2352x1568px; color fundus image — 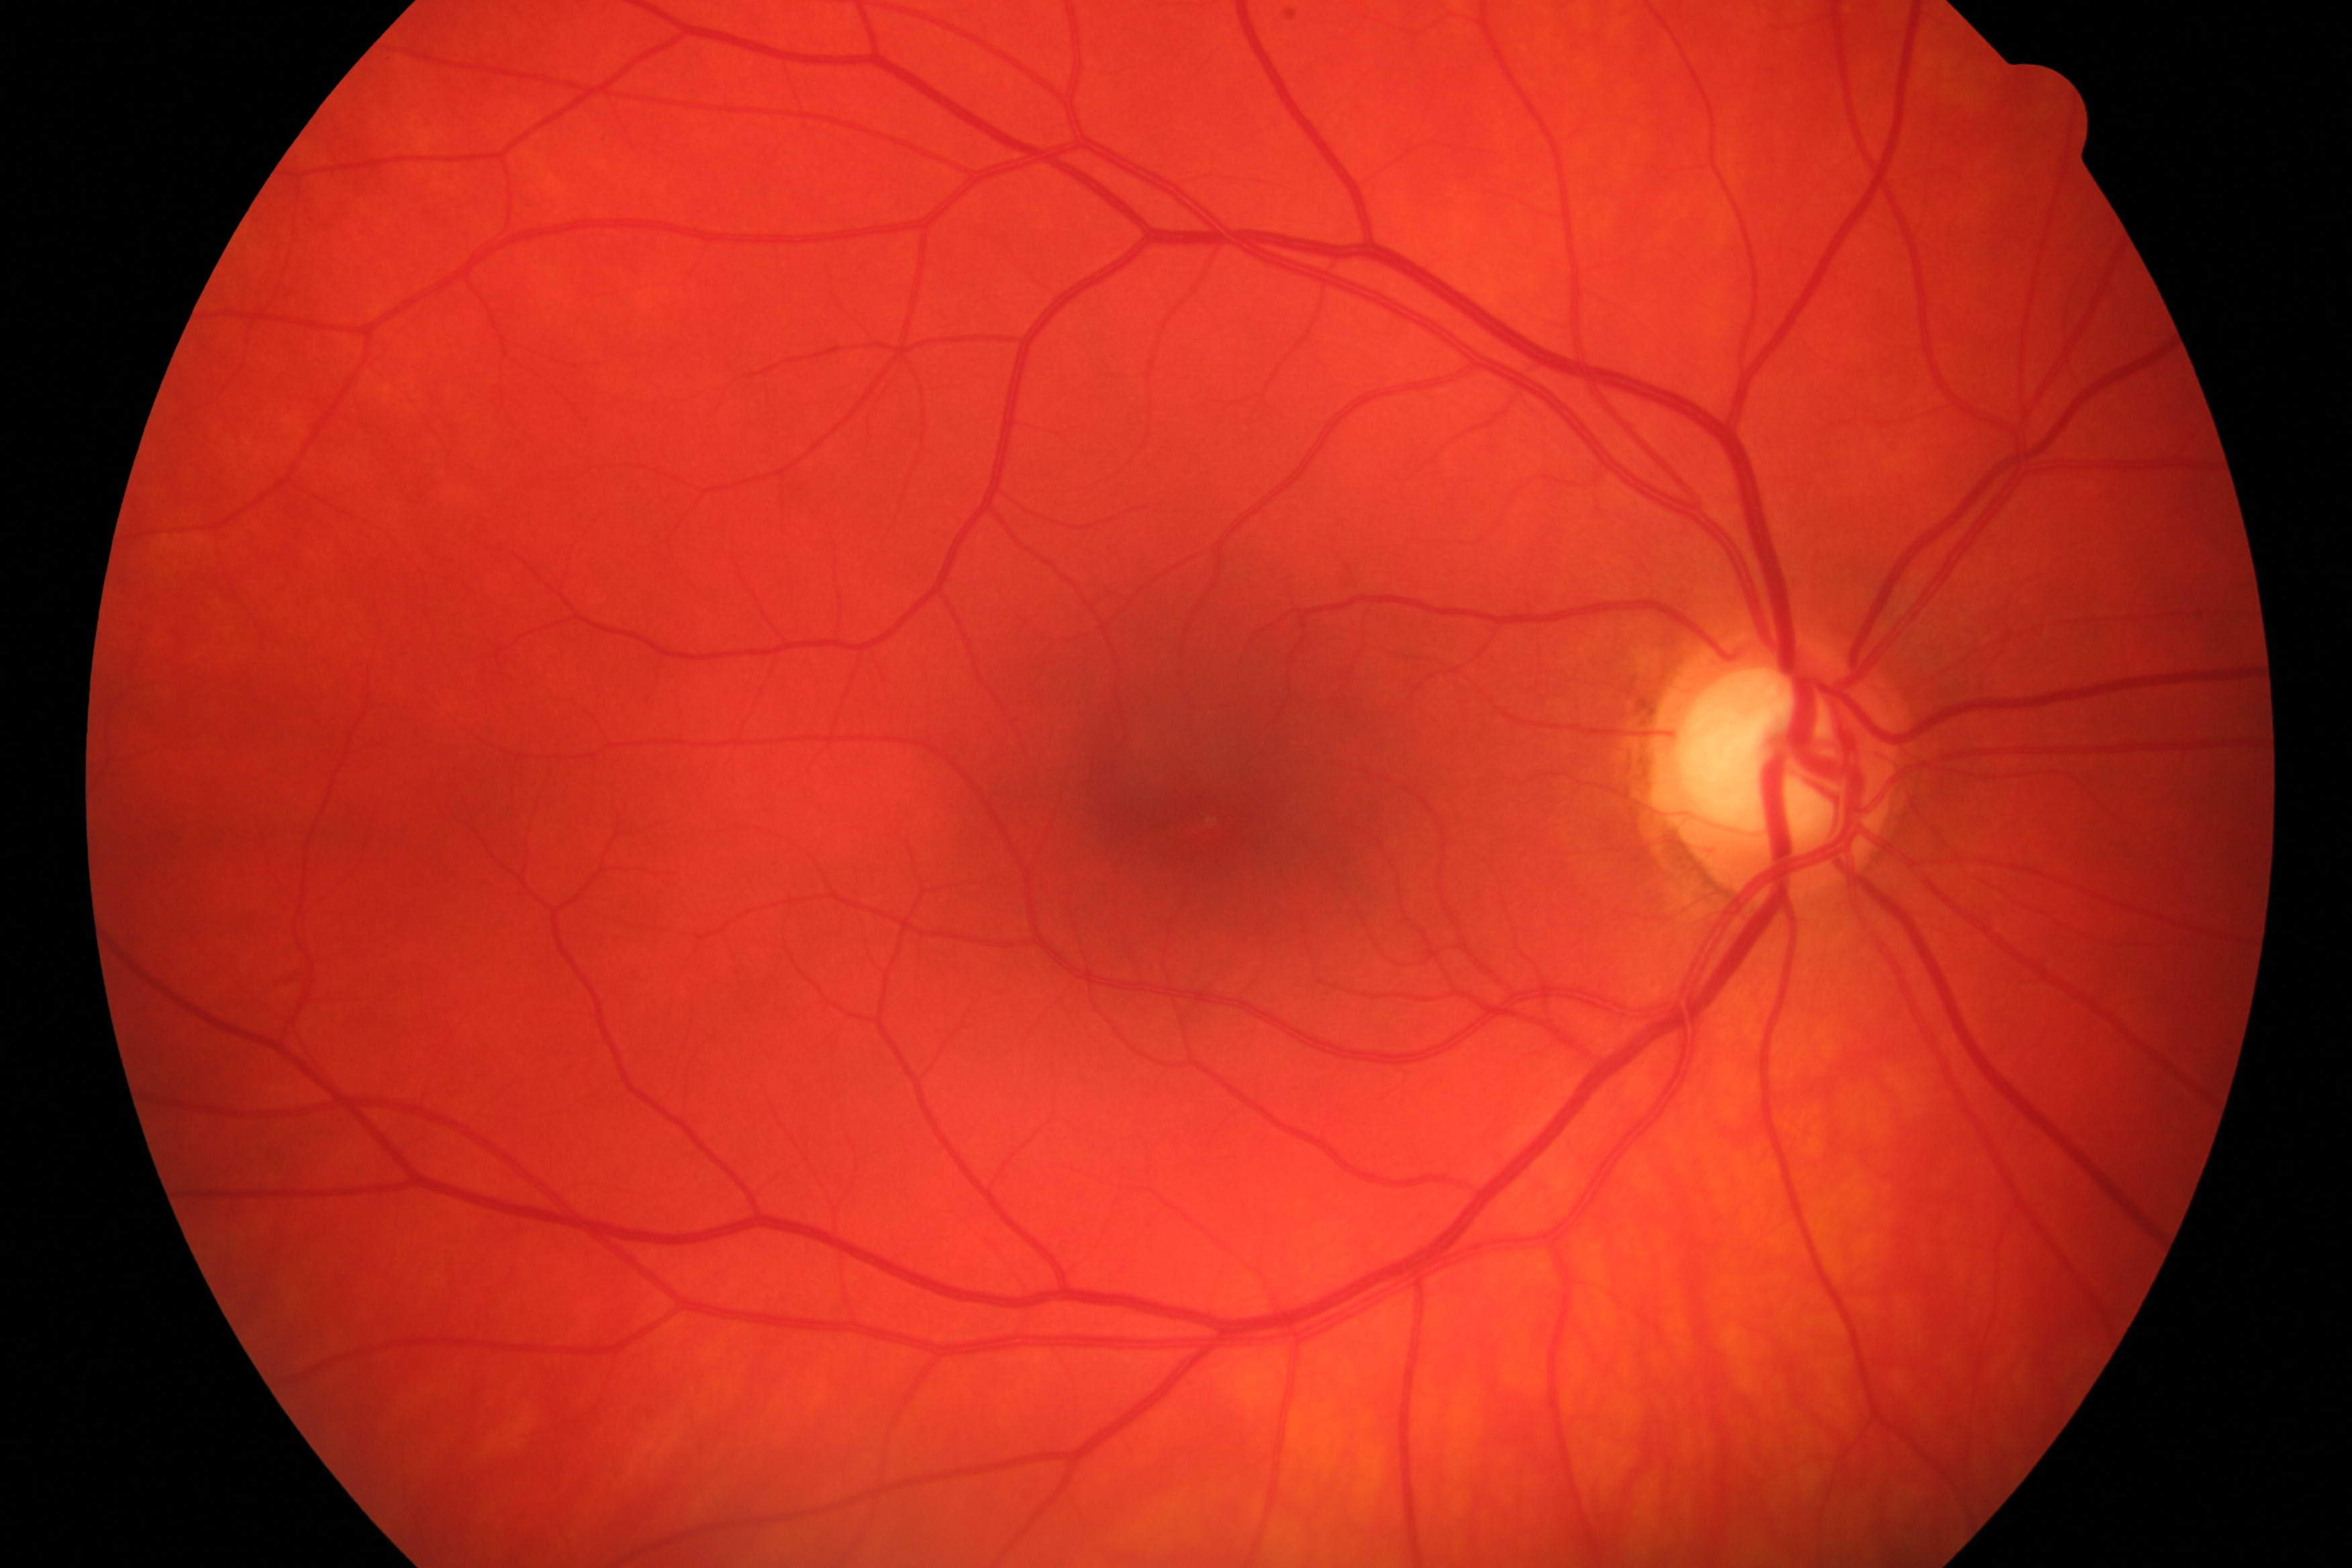
Showing glaucomatous damage.